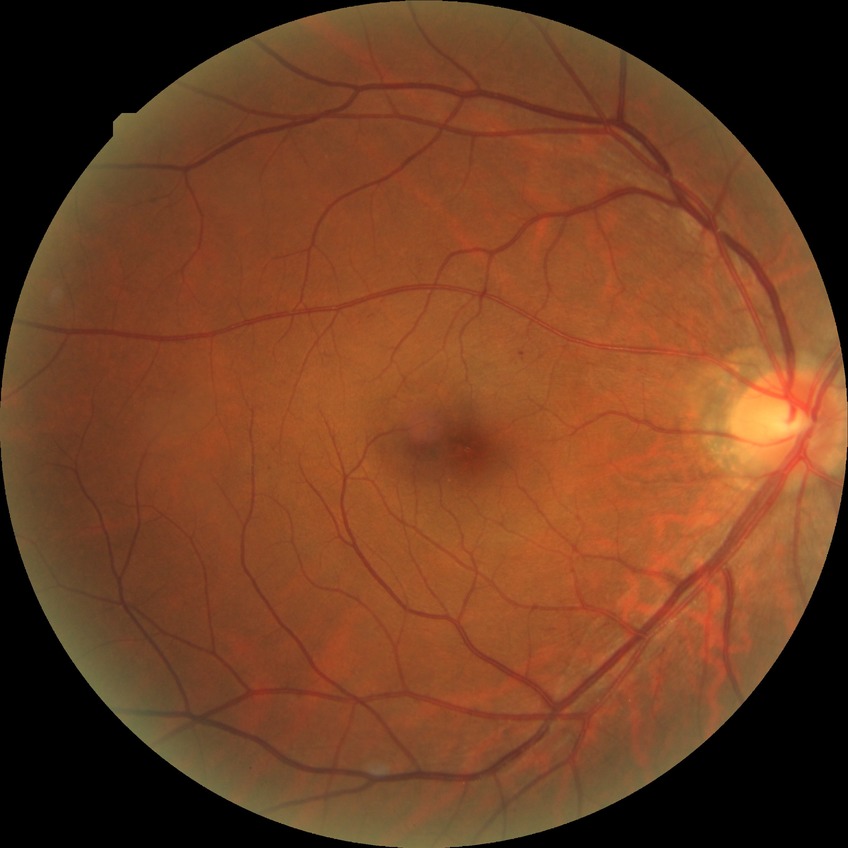
Davis DR grade is SDR.